Infant wide-field fundus photograph: 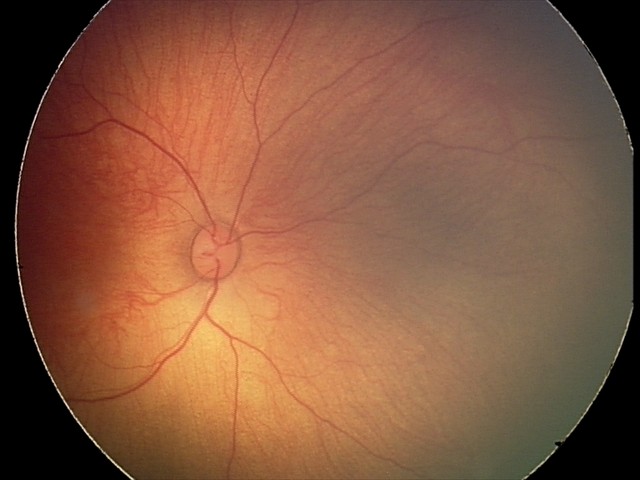 Screening examination consistent with retinal hemorrhages.